Color fundus photograph
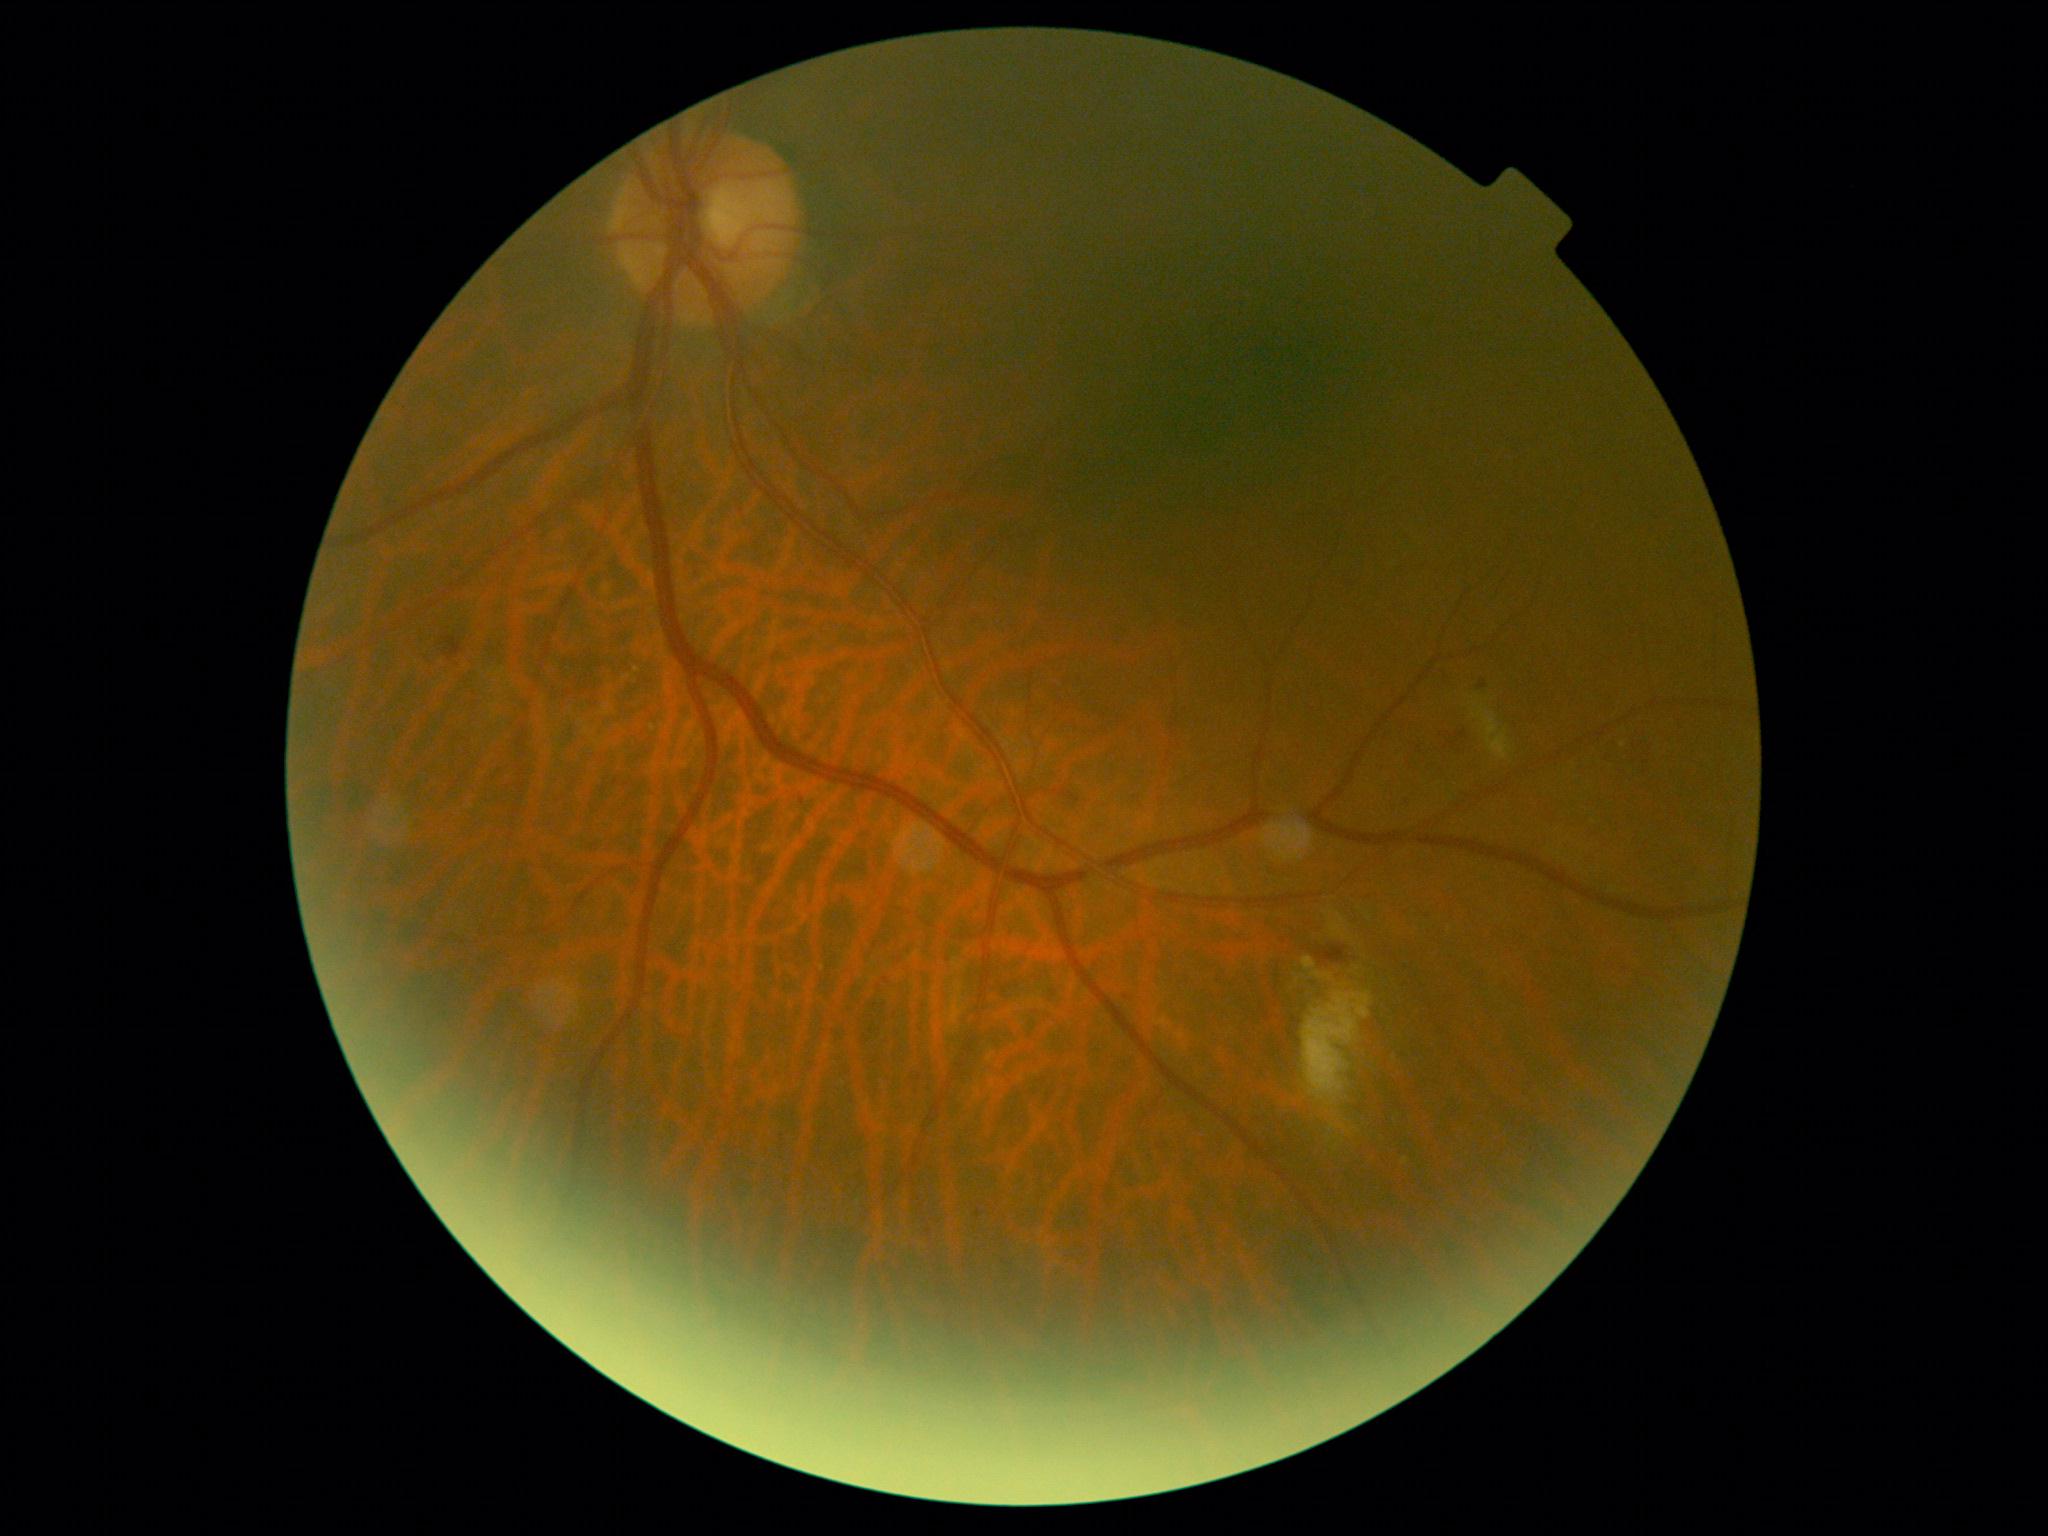   dr_category: non-proliferative diabetic retinopathy
  dr_grade: grade 2